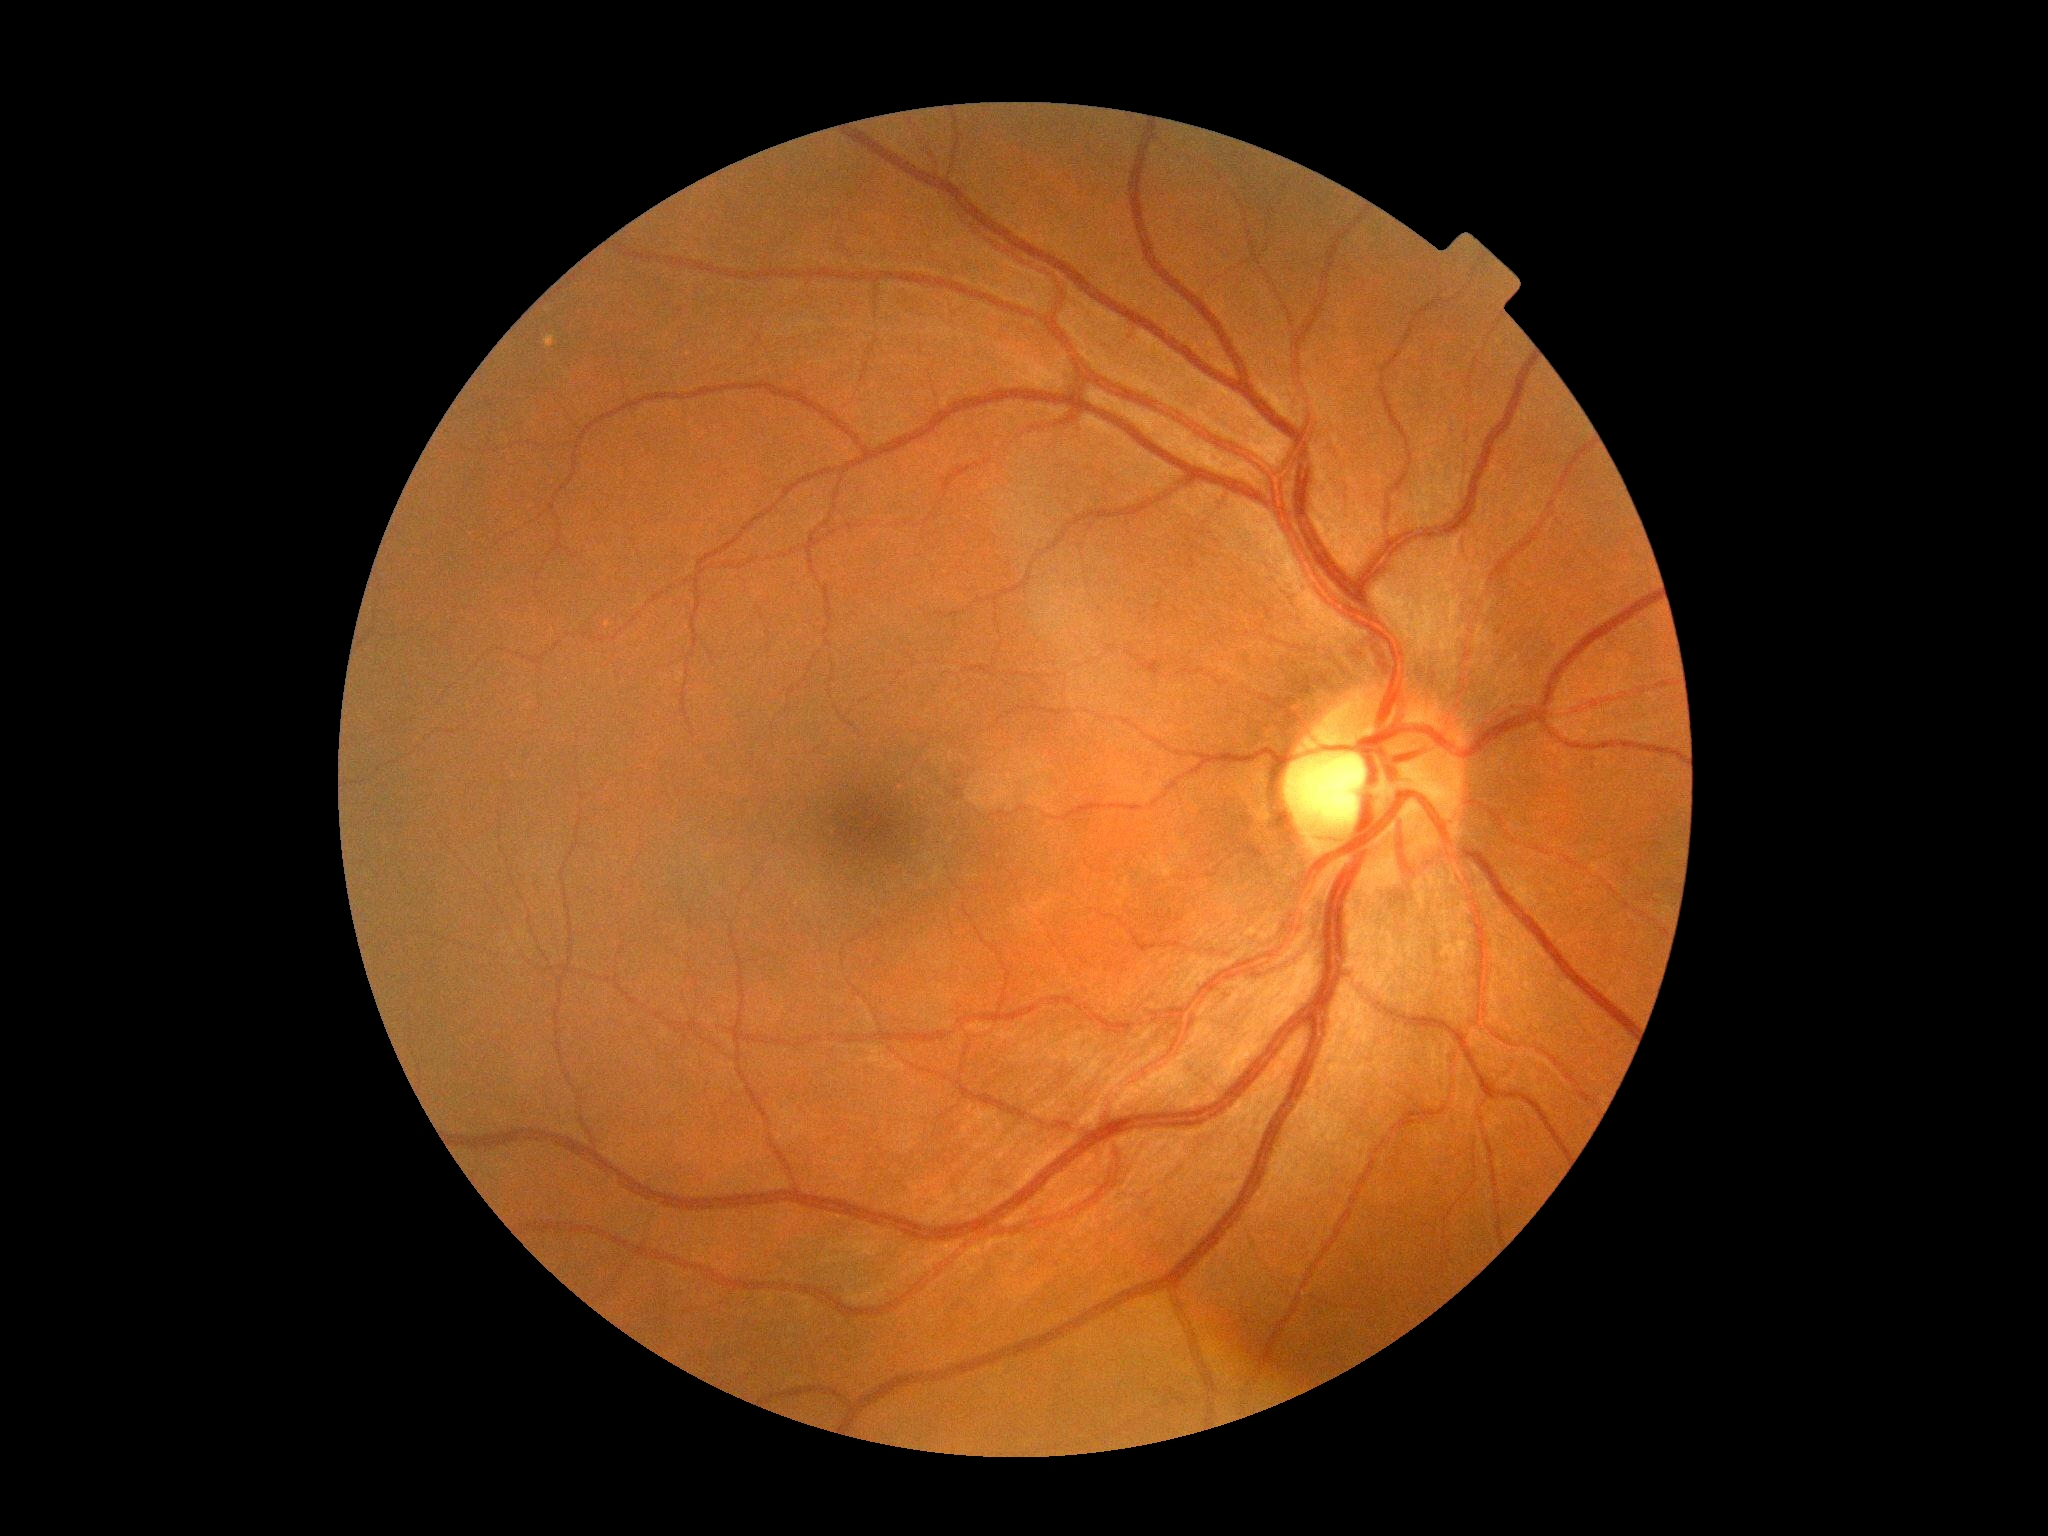

Diabetic retinopathy (DR) is grade 0 (no apparent retinopathy) — no visible signs of diabetic retinopathy. No signs of diabetic retinopathy.